Color fundus photograph centered on the optic disc, 35° FOV before cropping
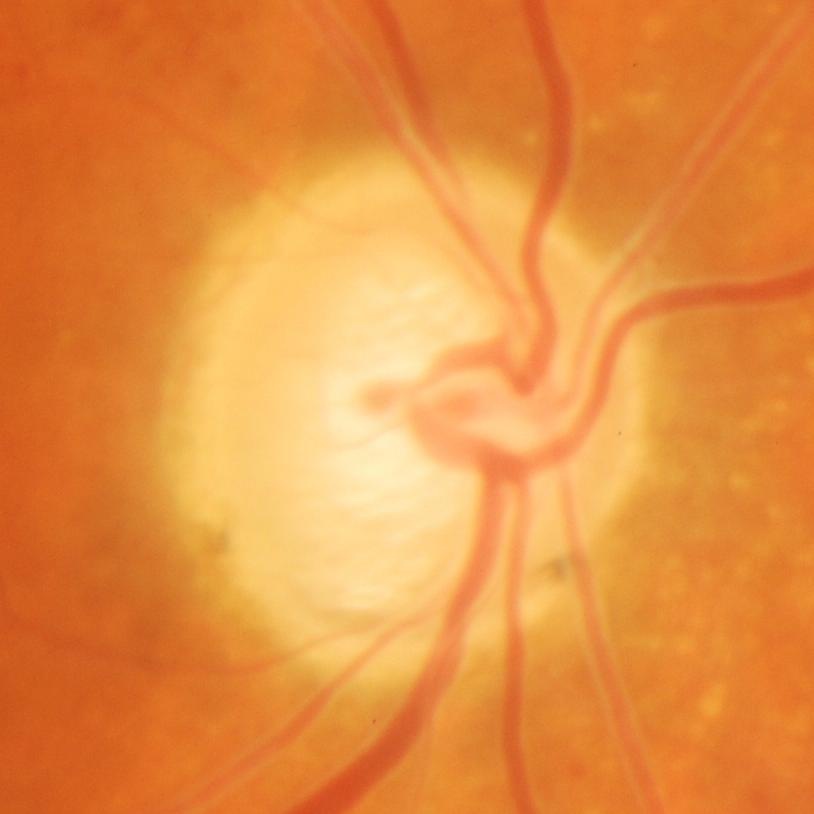

Demonstrates glaucomatous optic neuropathy.